Camera: NIDEK AFC-230
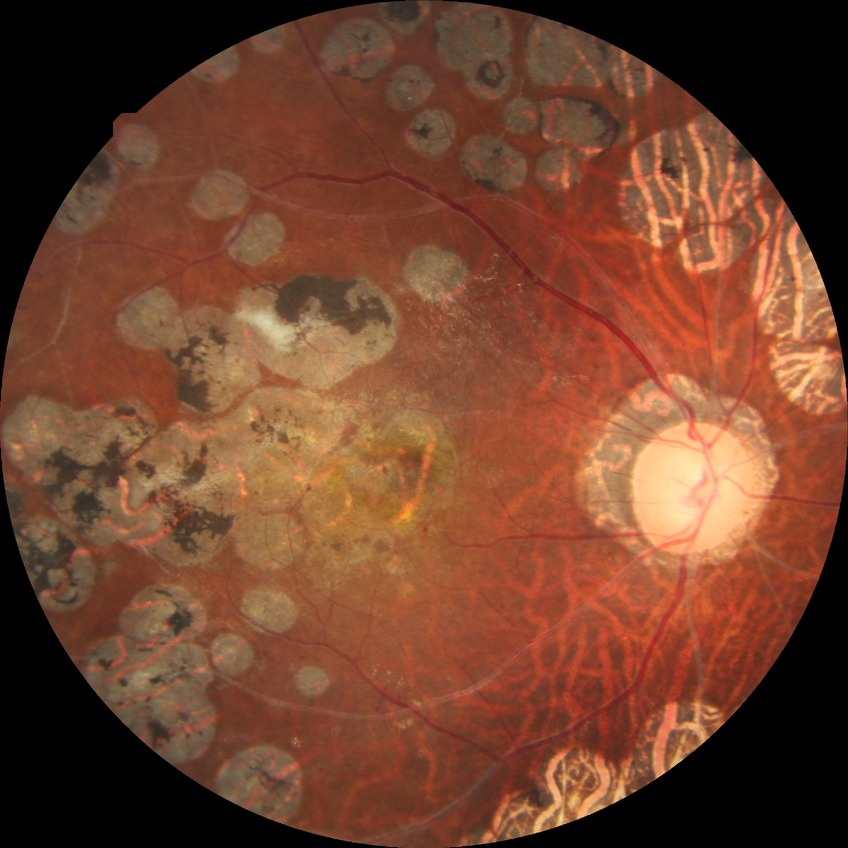 davis_grade: proliferative diabetic retinopathy